Captured with the Phoenix ICON (100° field of view). Phoenix ICON wide-field infant fundus image — 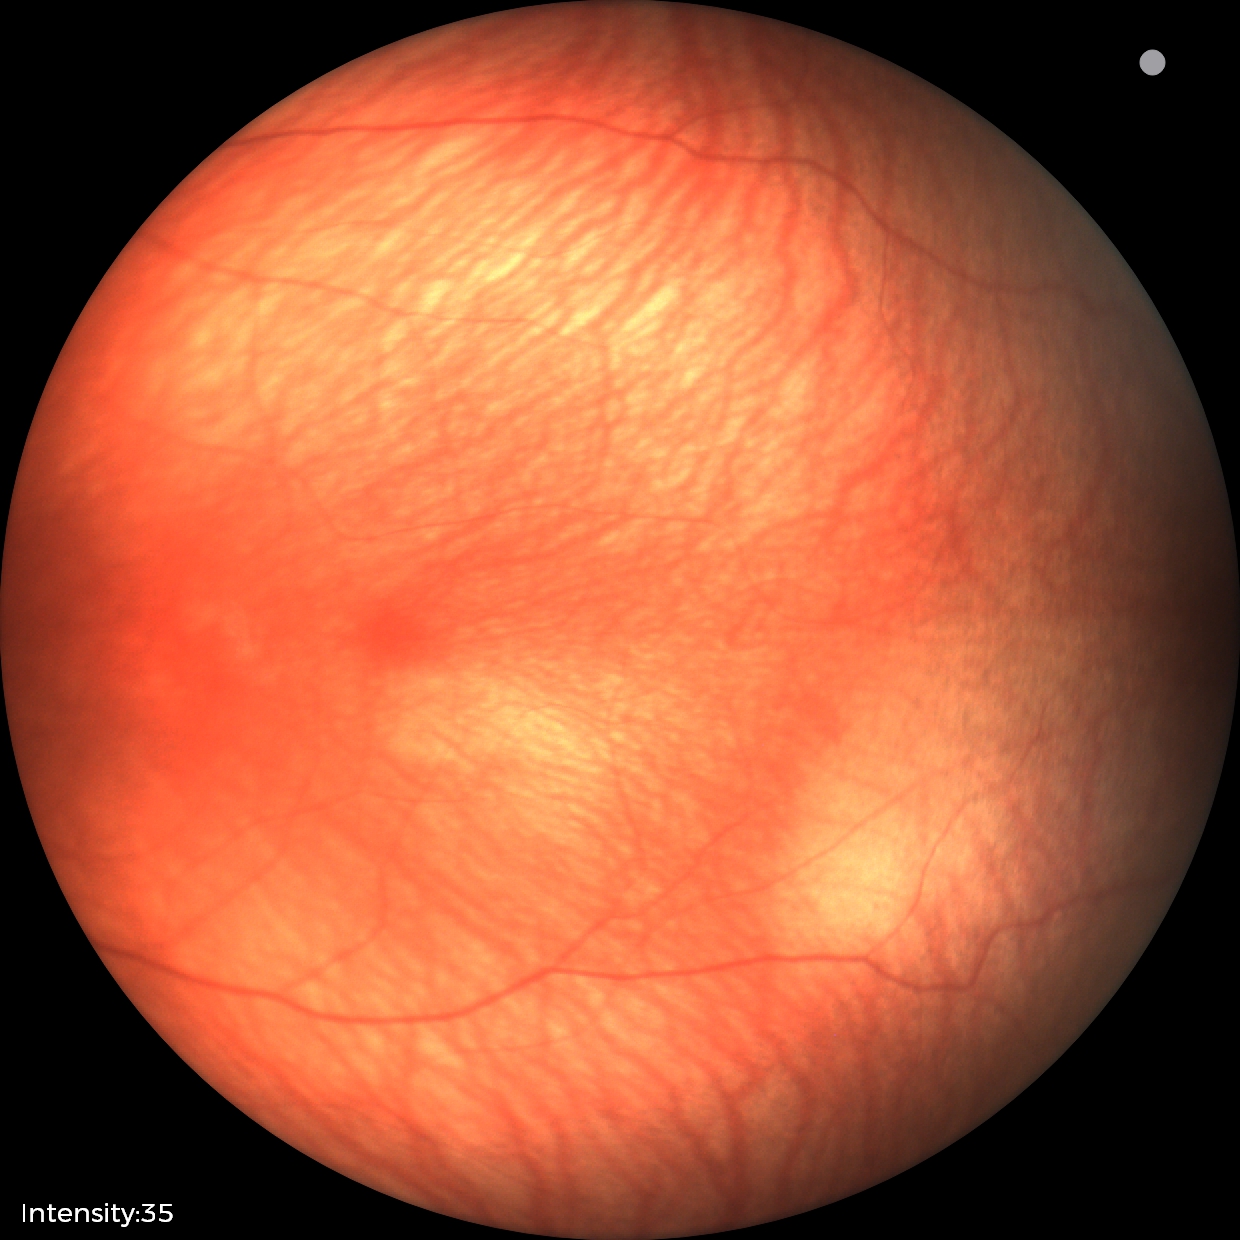 No retinal pathology identified on screening.